1380x1382:
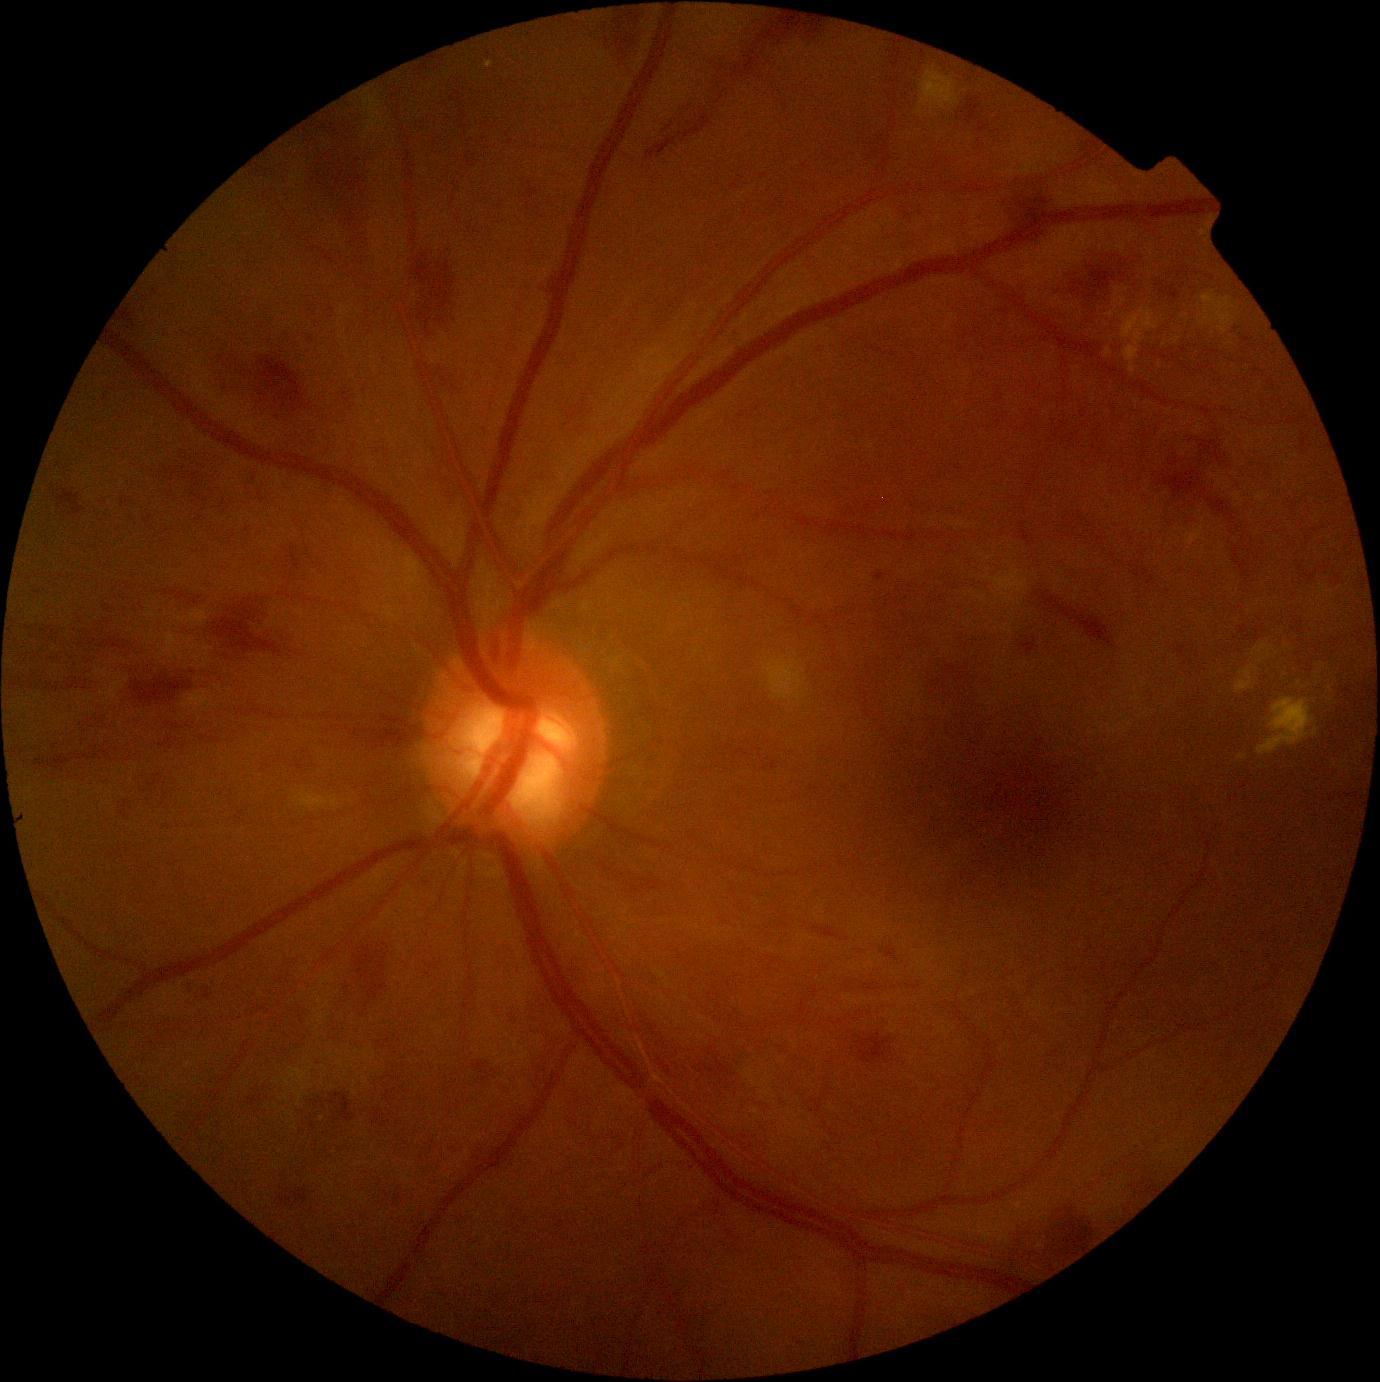 Retinopathy grade is moderate non-proliferative diabetic retinopathy (2). Disease class: non-proliferative diabetic retinopathy.